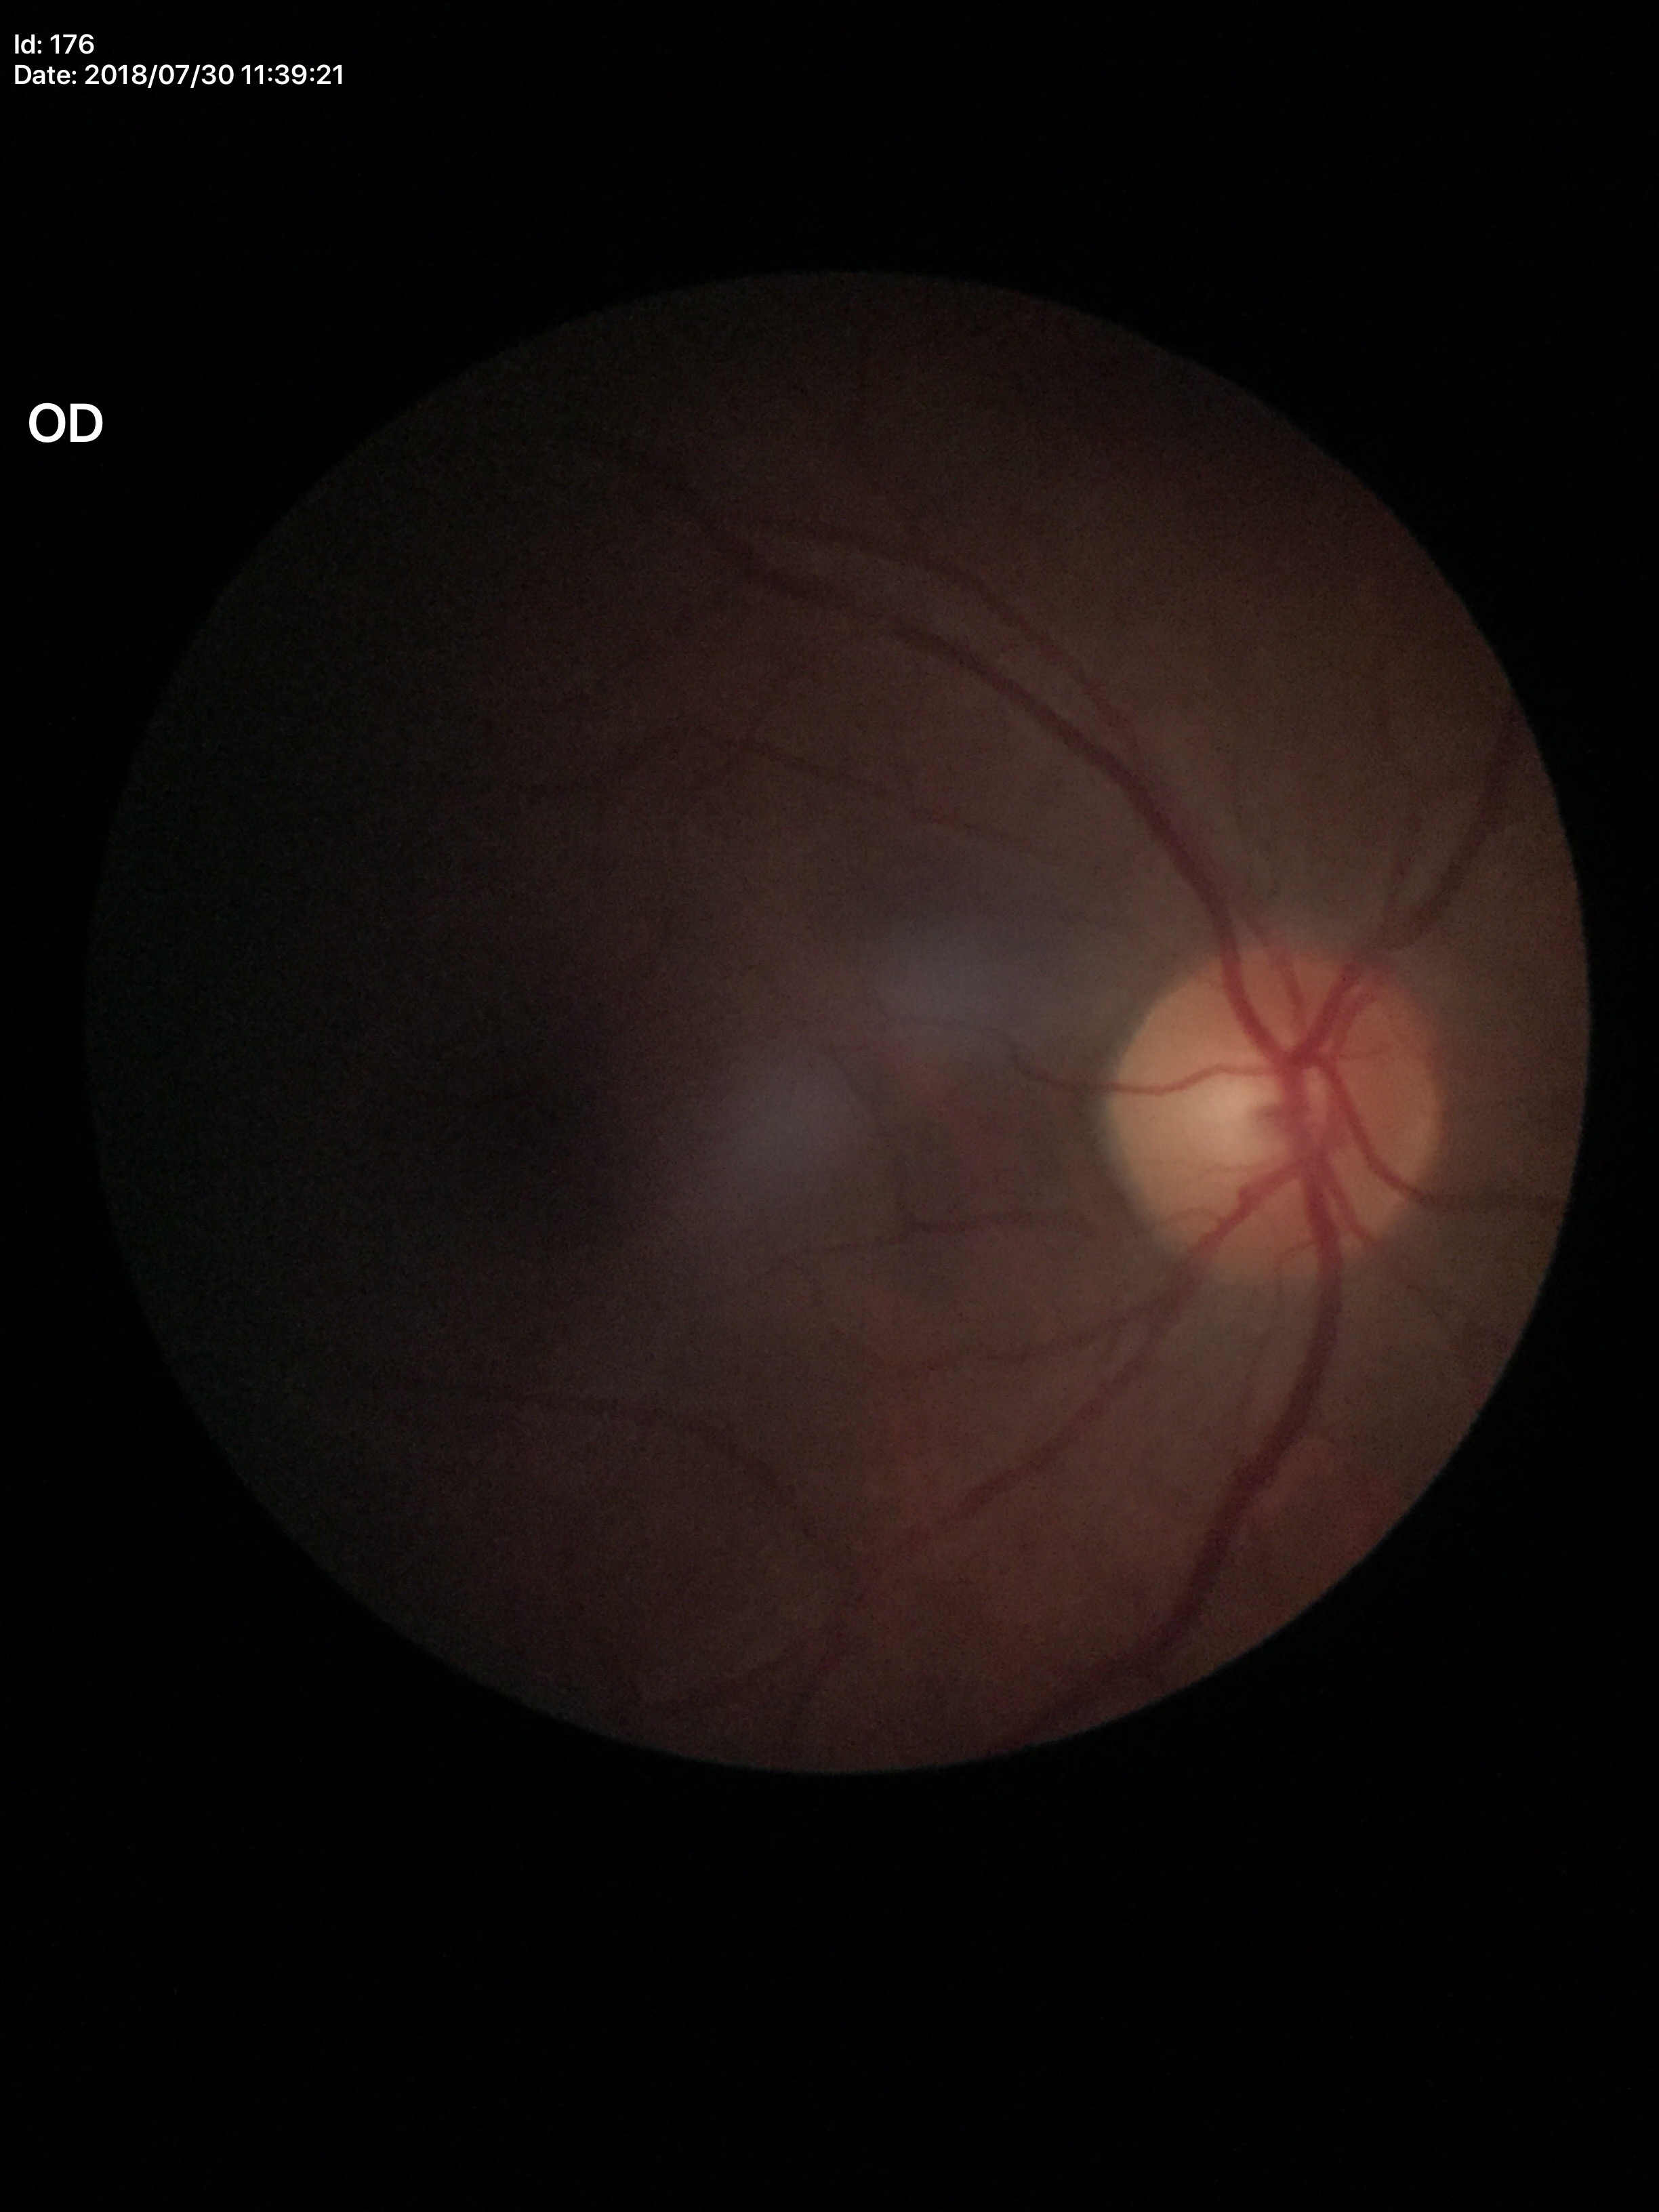 Q: What is the VCDR?
A: 0.47
Q: Is there glaucoma suspicion?
A: no suspicious findings